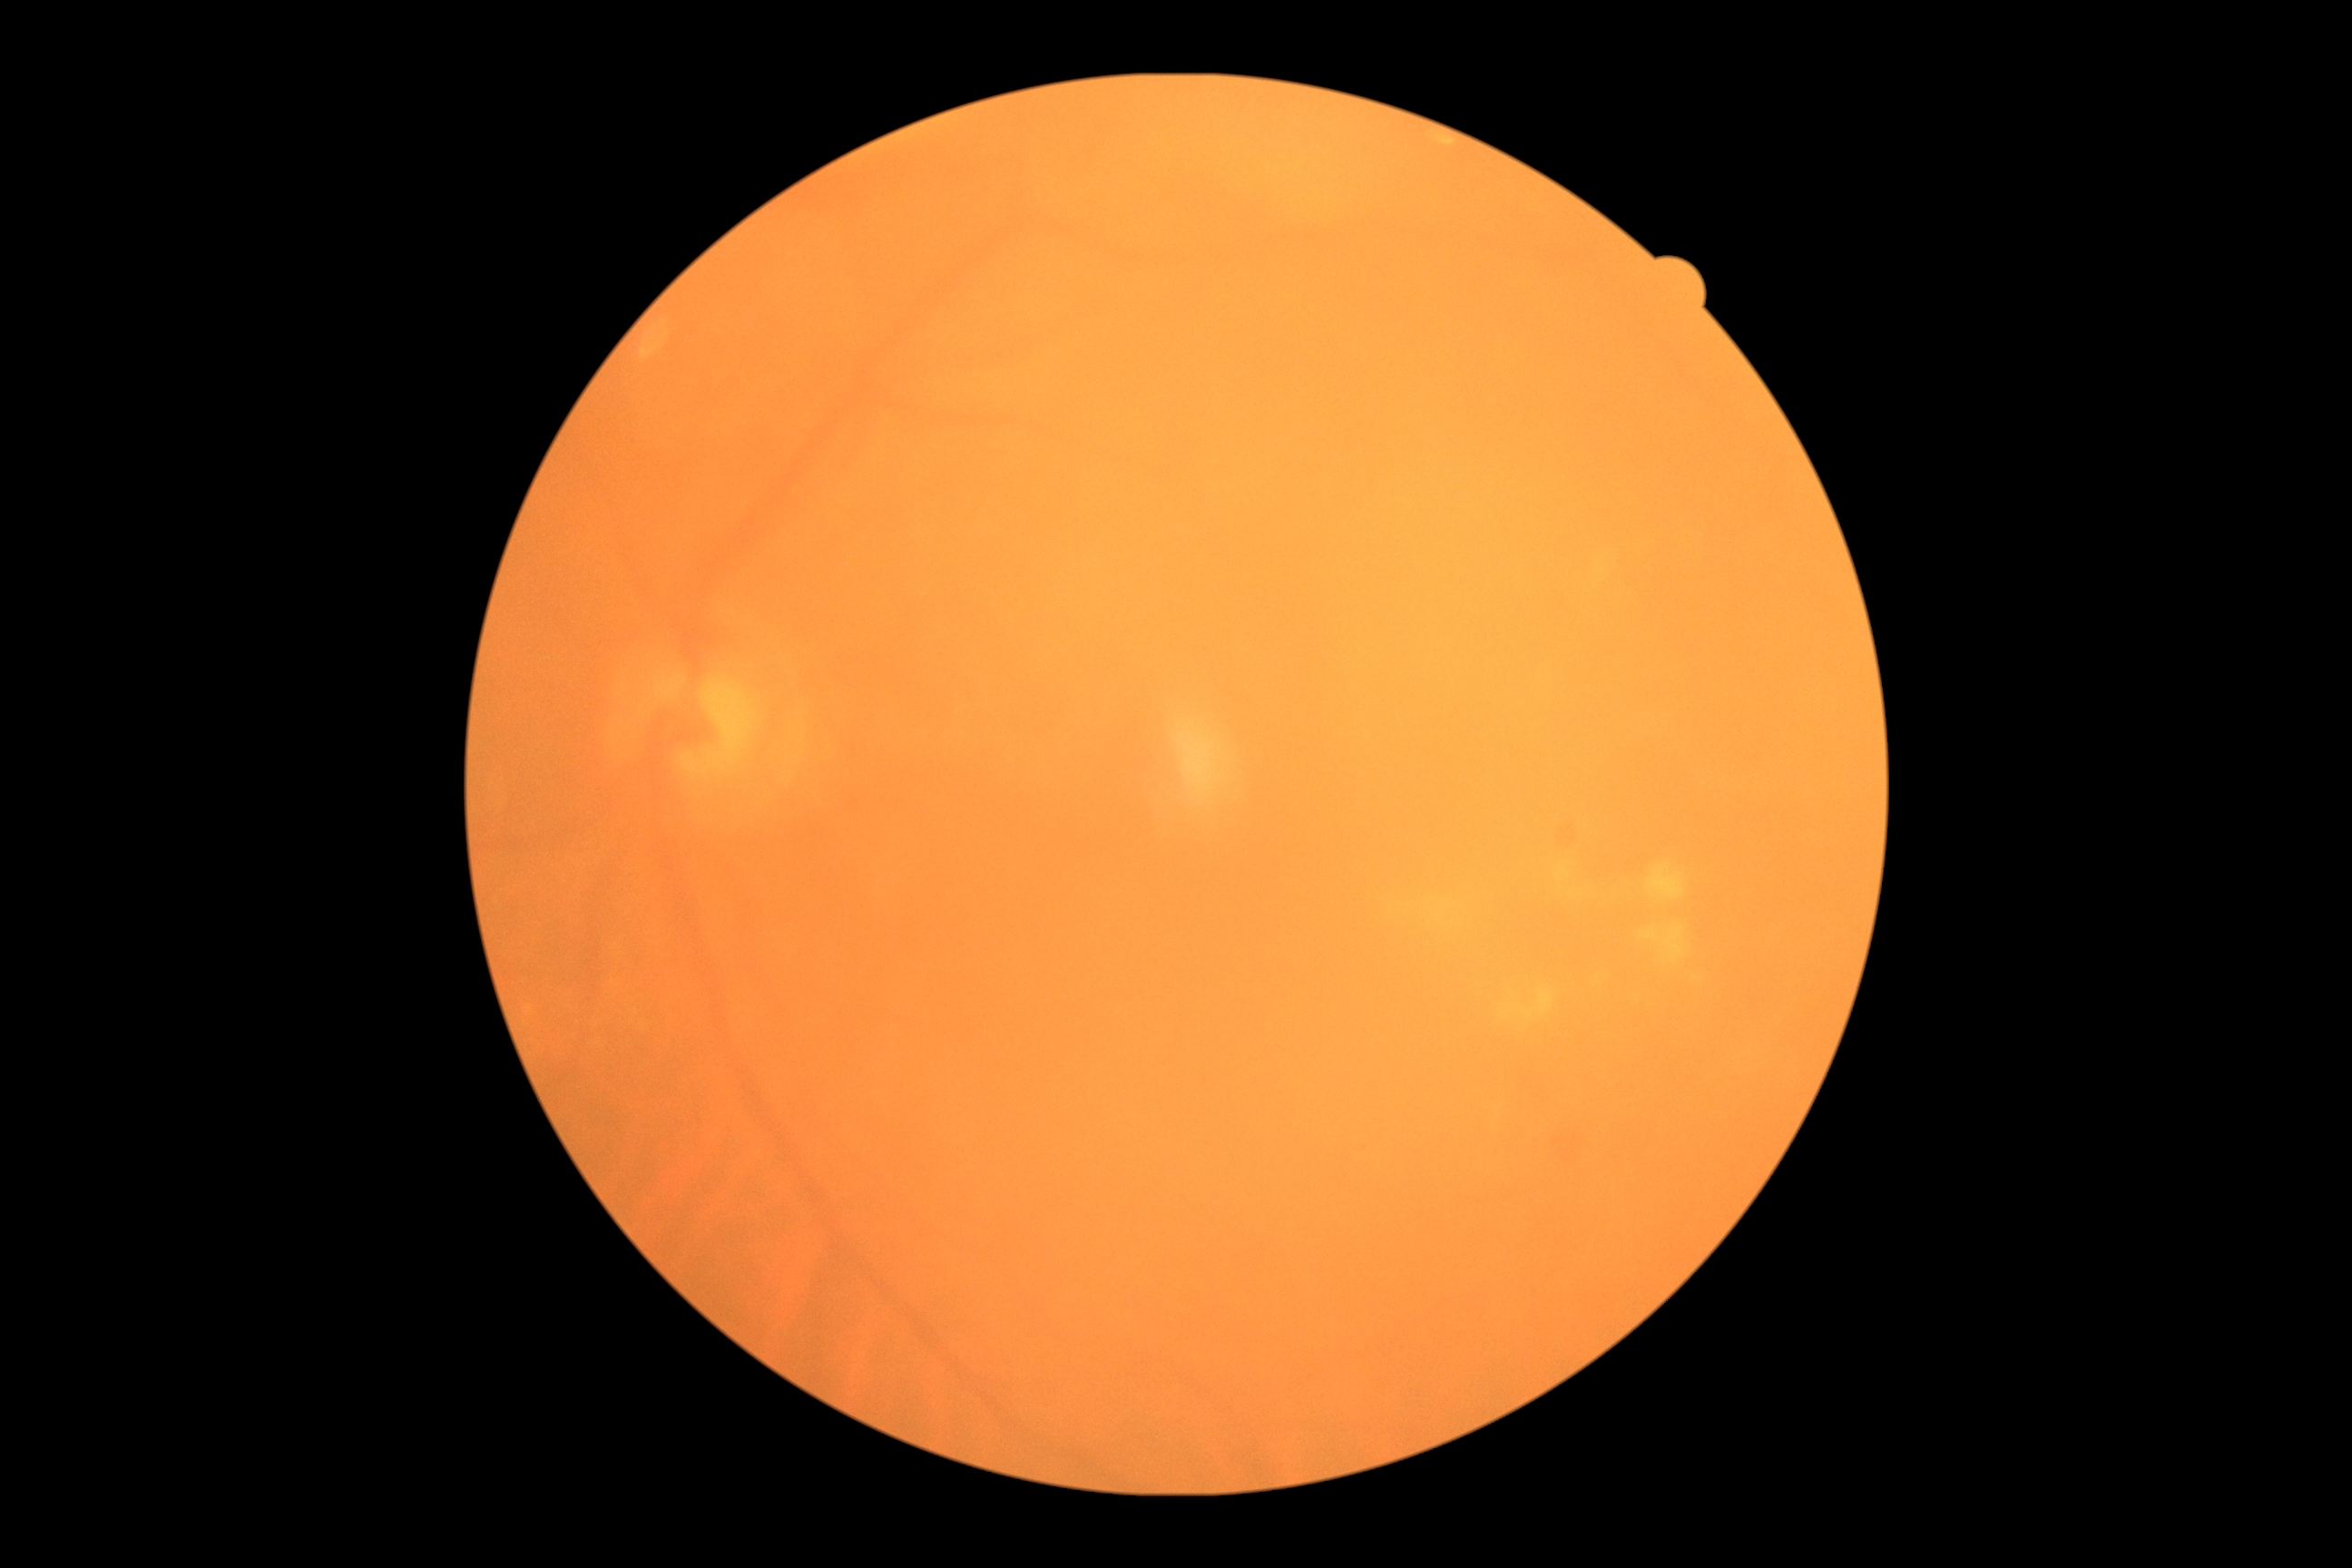

  dr_grade: moderate NPDR (grade 2)